Phoenix ICON, 100° FOV; image size 1240x1240; pediatric wide-field fundus photograph:
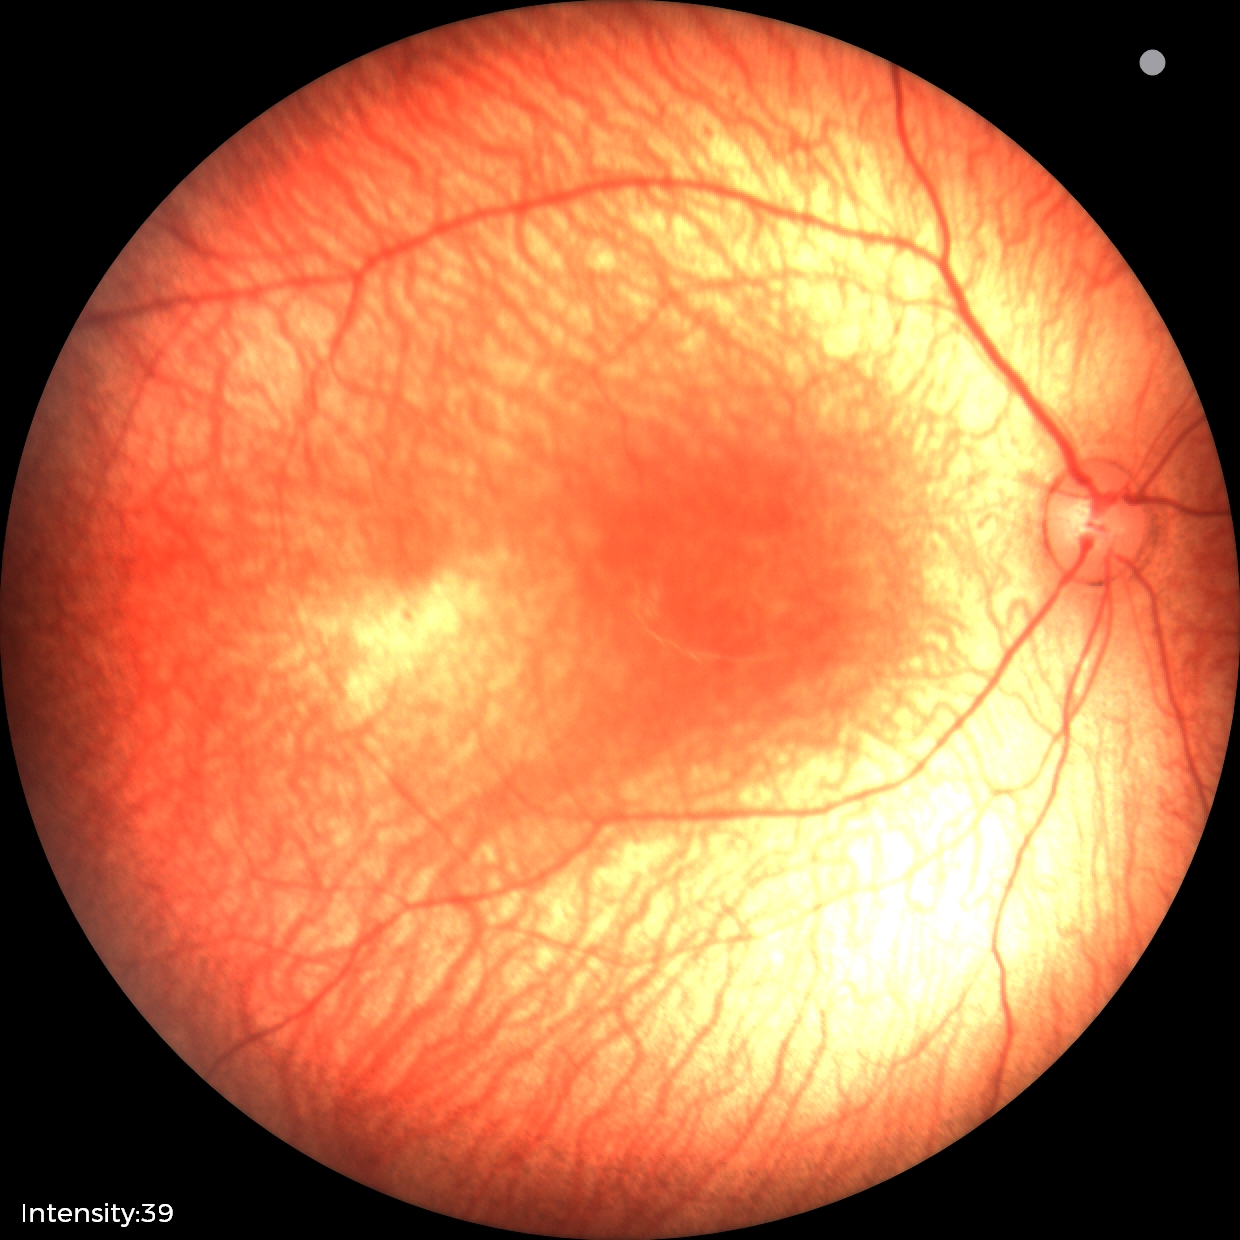
Examination with physiological retinal findings.